200° field of view, 1924 x 1556 pixels, ultra-widefield fundus mosaic.
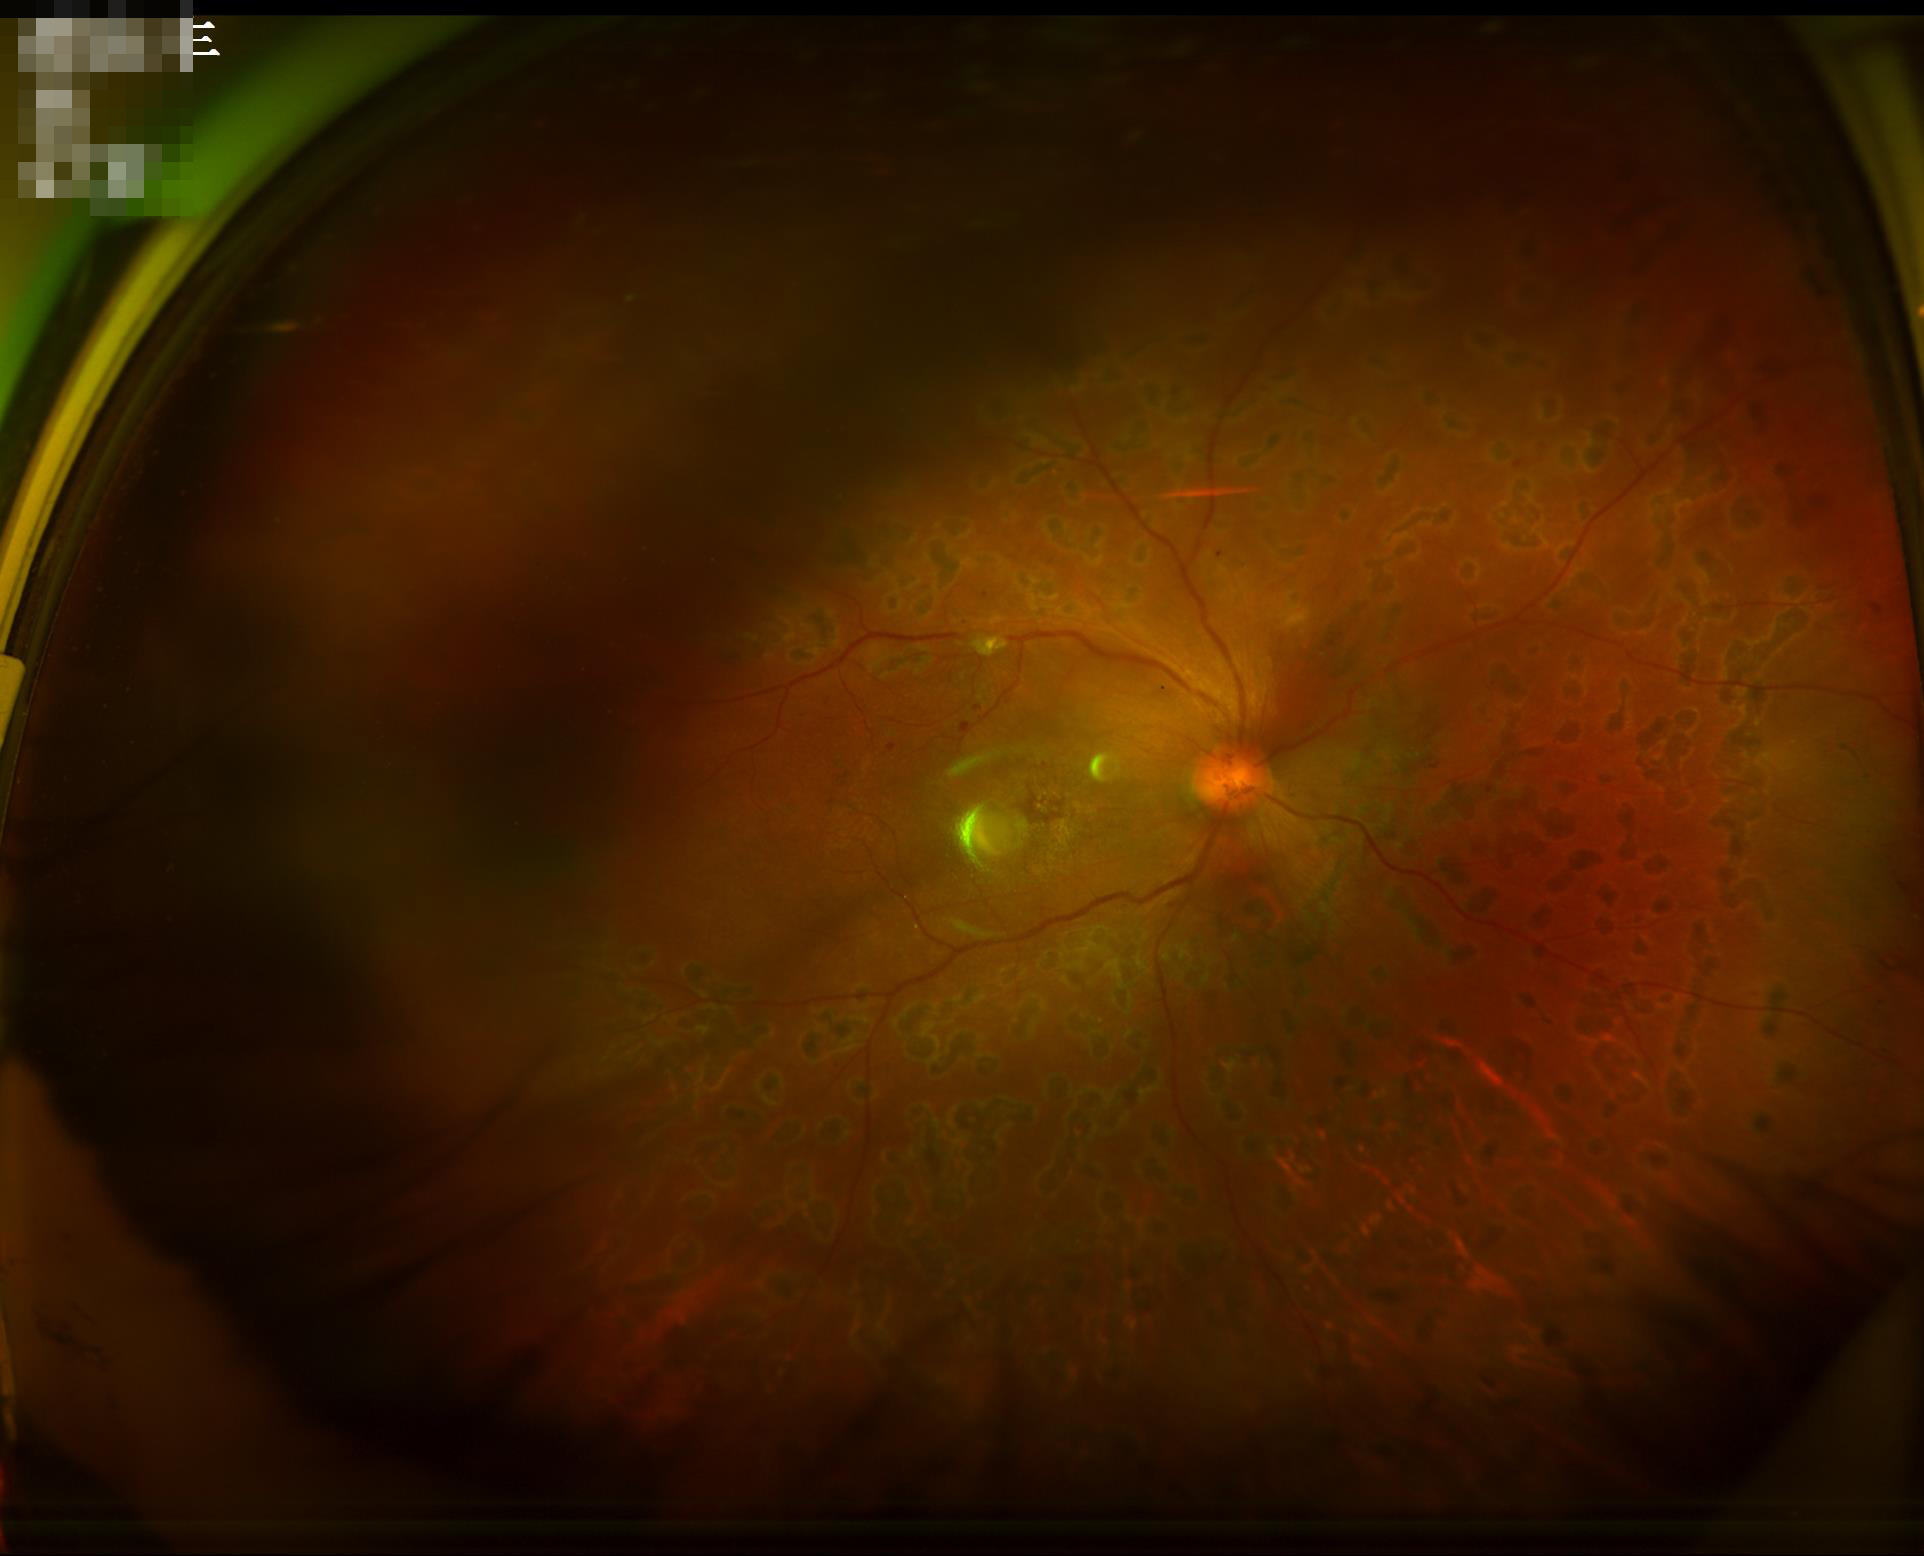
{"clarity": "out of focus, structures indistinct", "contrast": "wide intensity range, structures distinguishable", "overall_quality": "poor, ungradable", "illumination": "over- or under-exposed"}